2212 x 1659 pixels · retinal fundus photograph
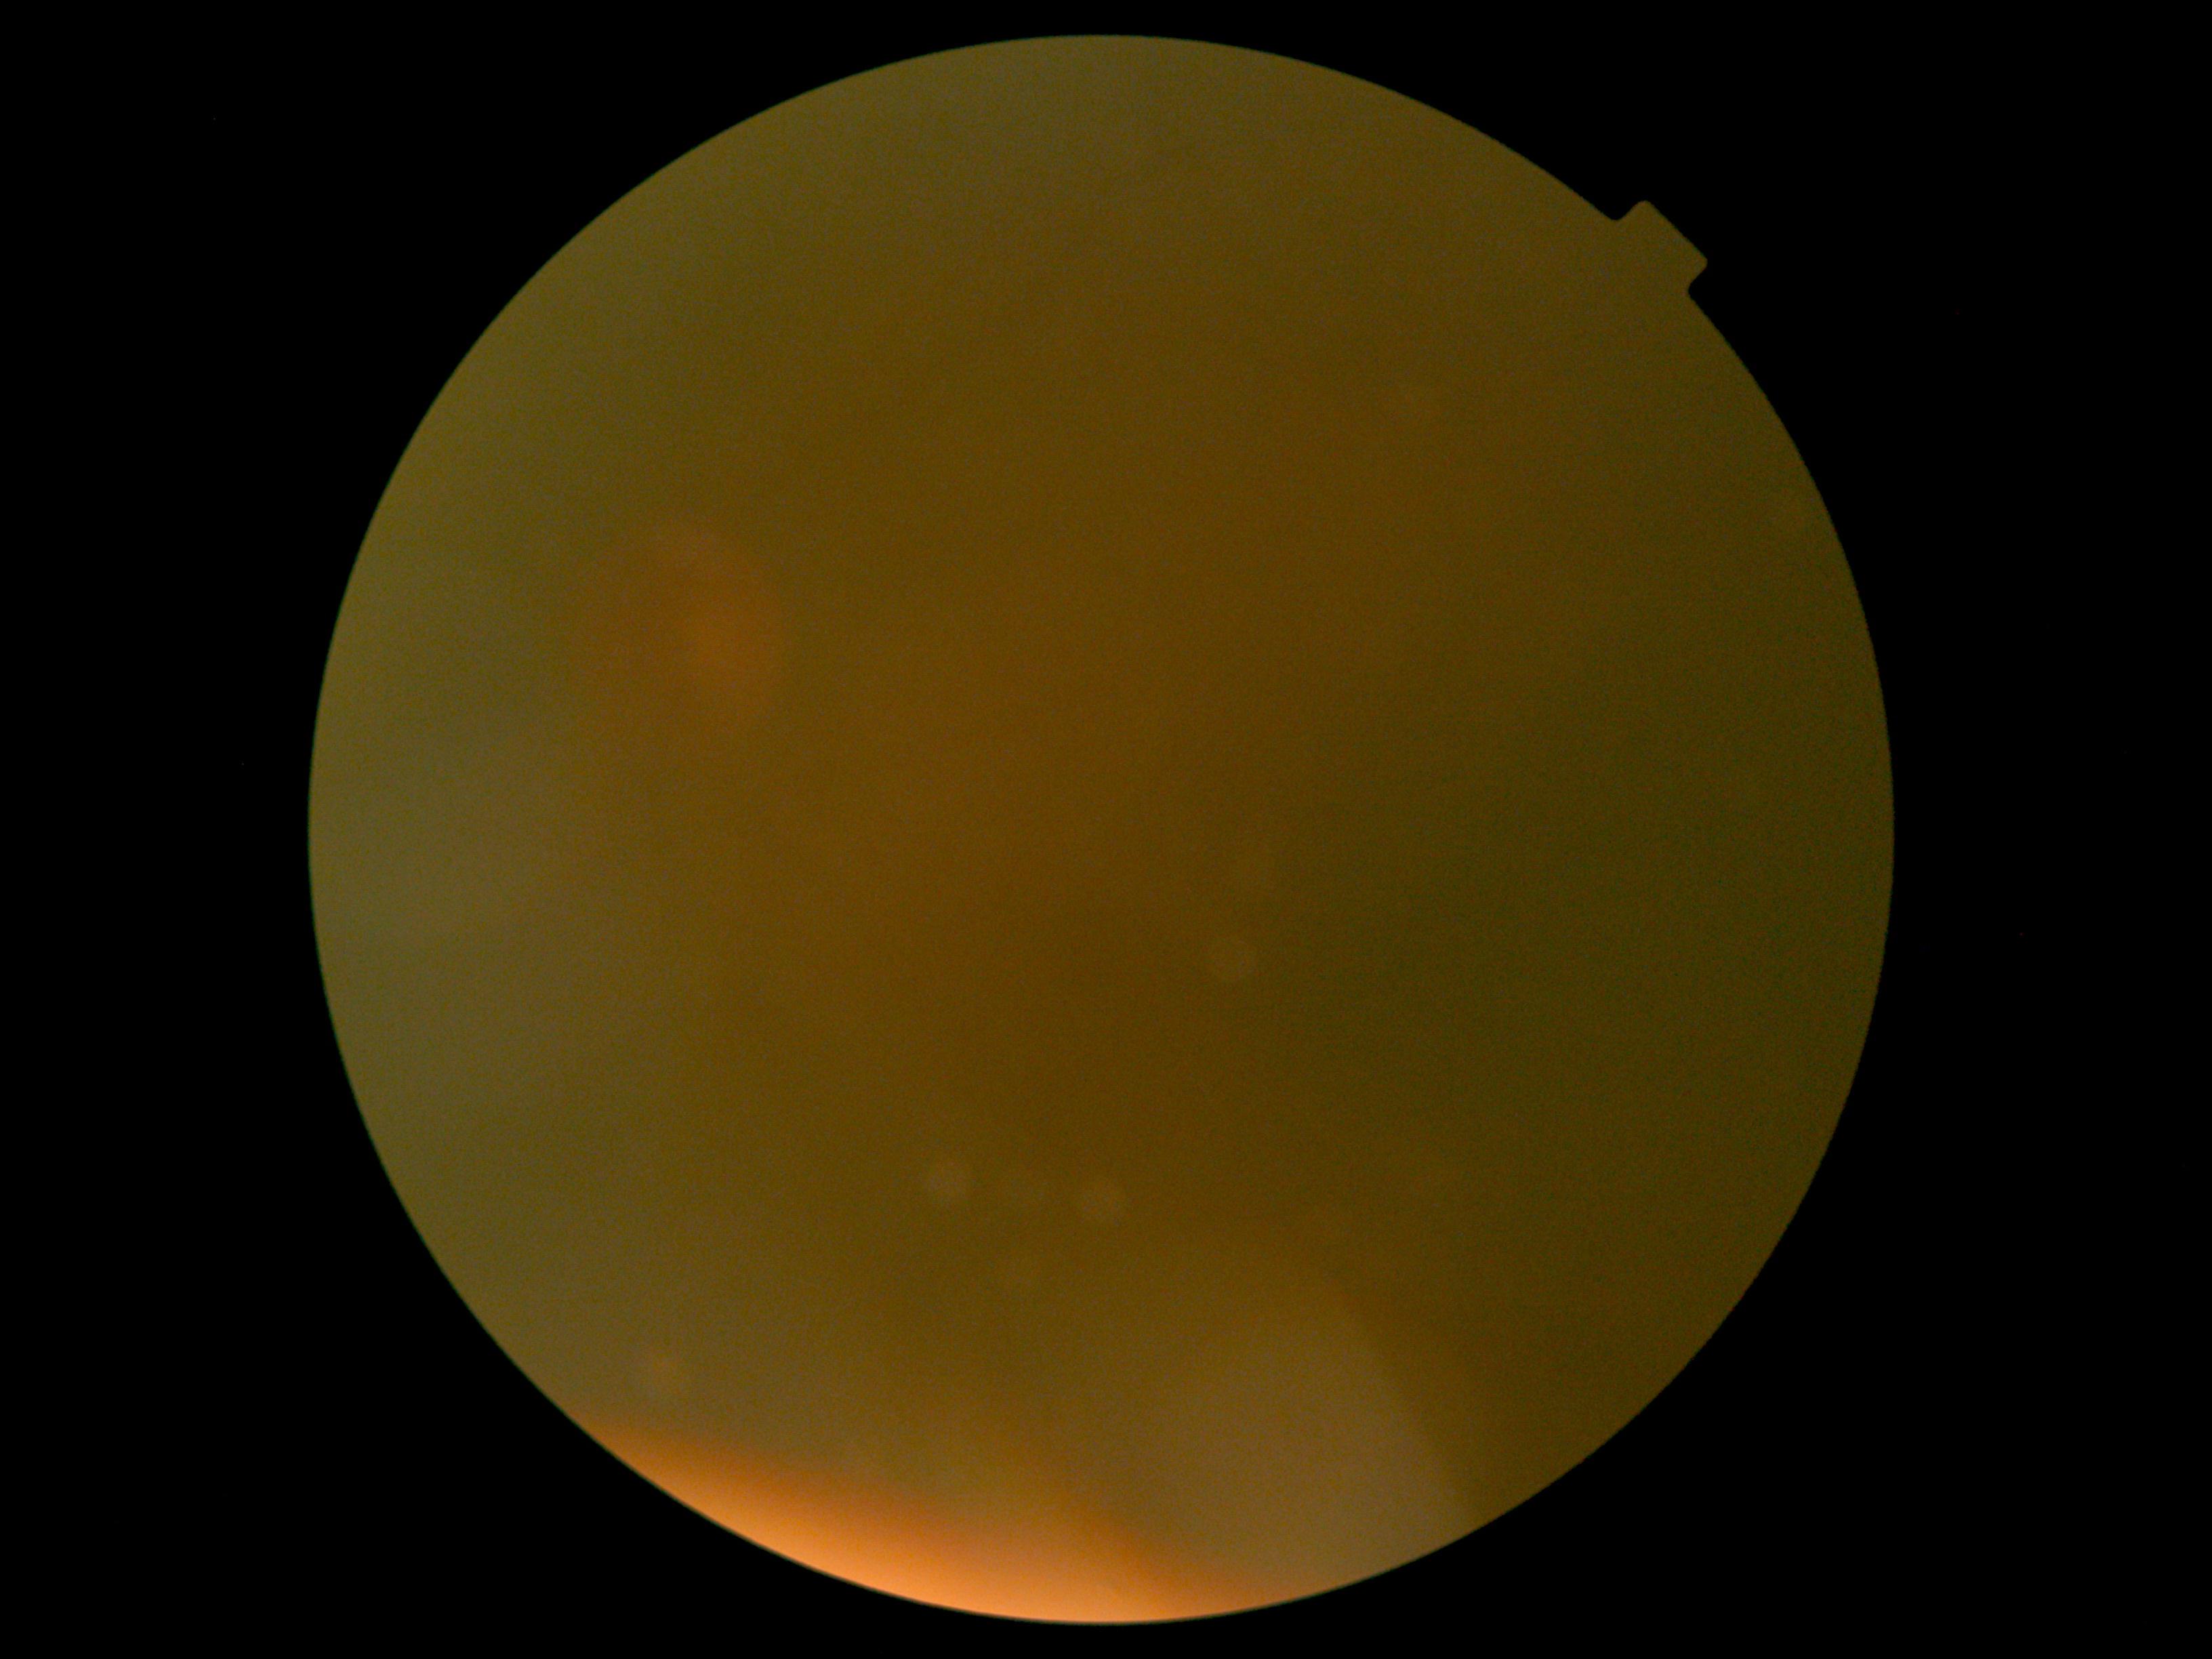

diabetic retinopathy (DR)=ungradable.